Image size 1659x2212
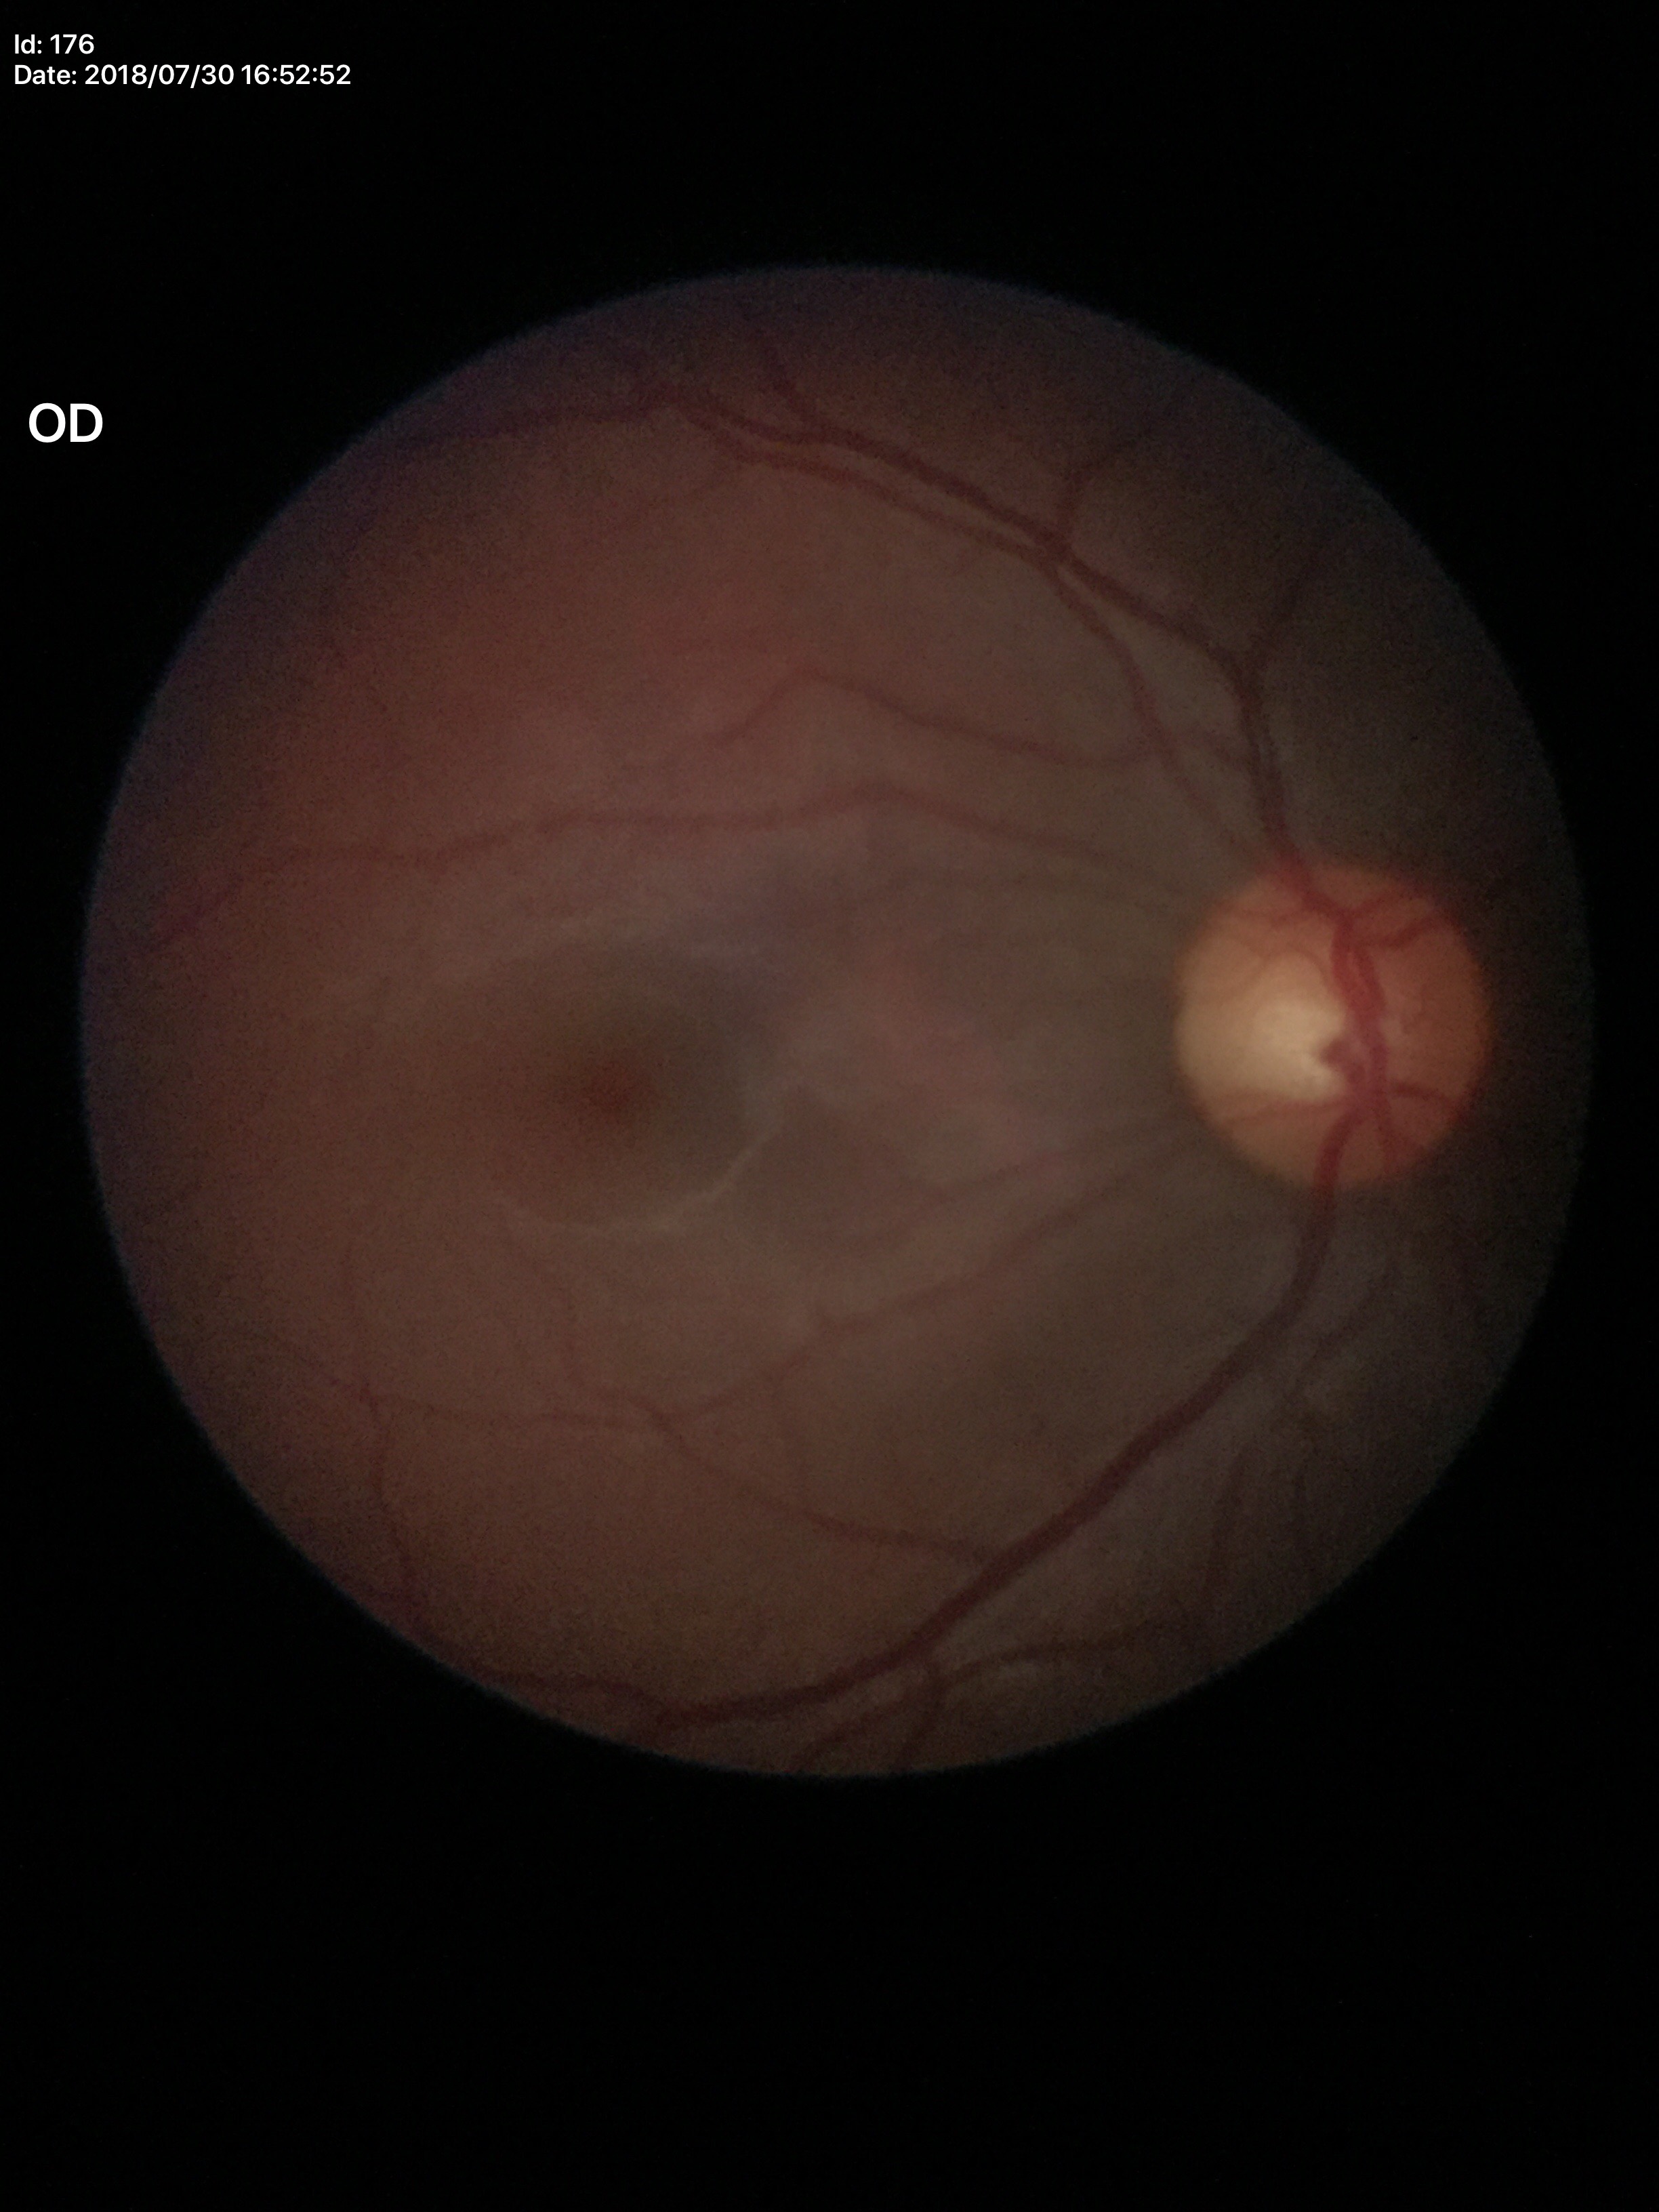 Horizontal cup-disc ratio: 0.53. Glaucoma decision: negative (1/5 graders called glaucoma suspect). Vertical cup-to-disc ratio of 0.54.